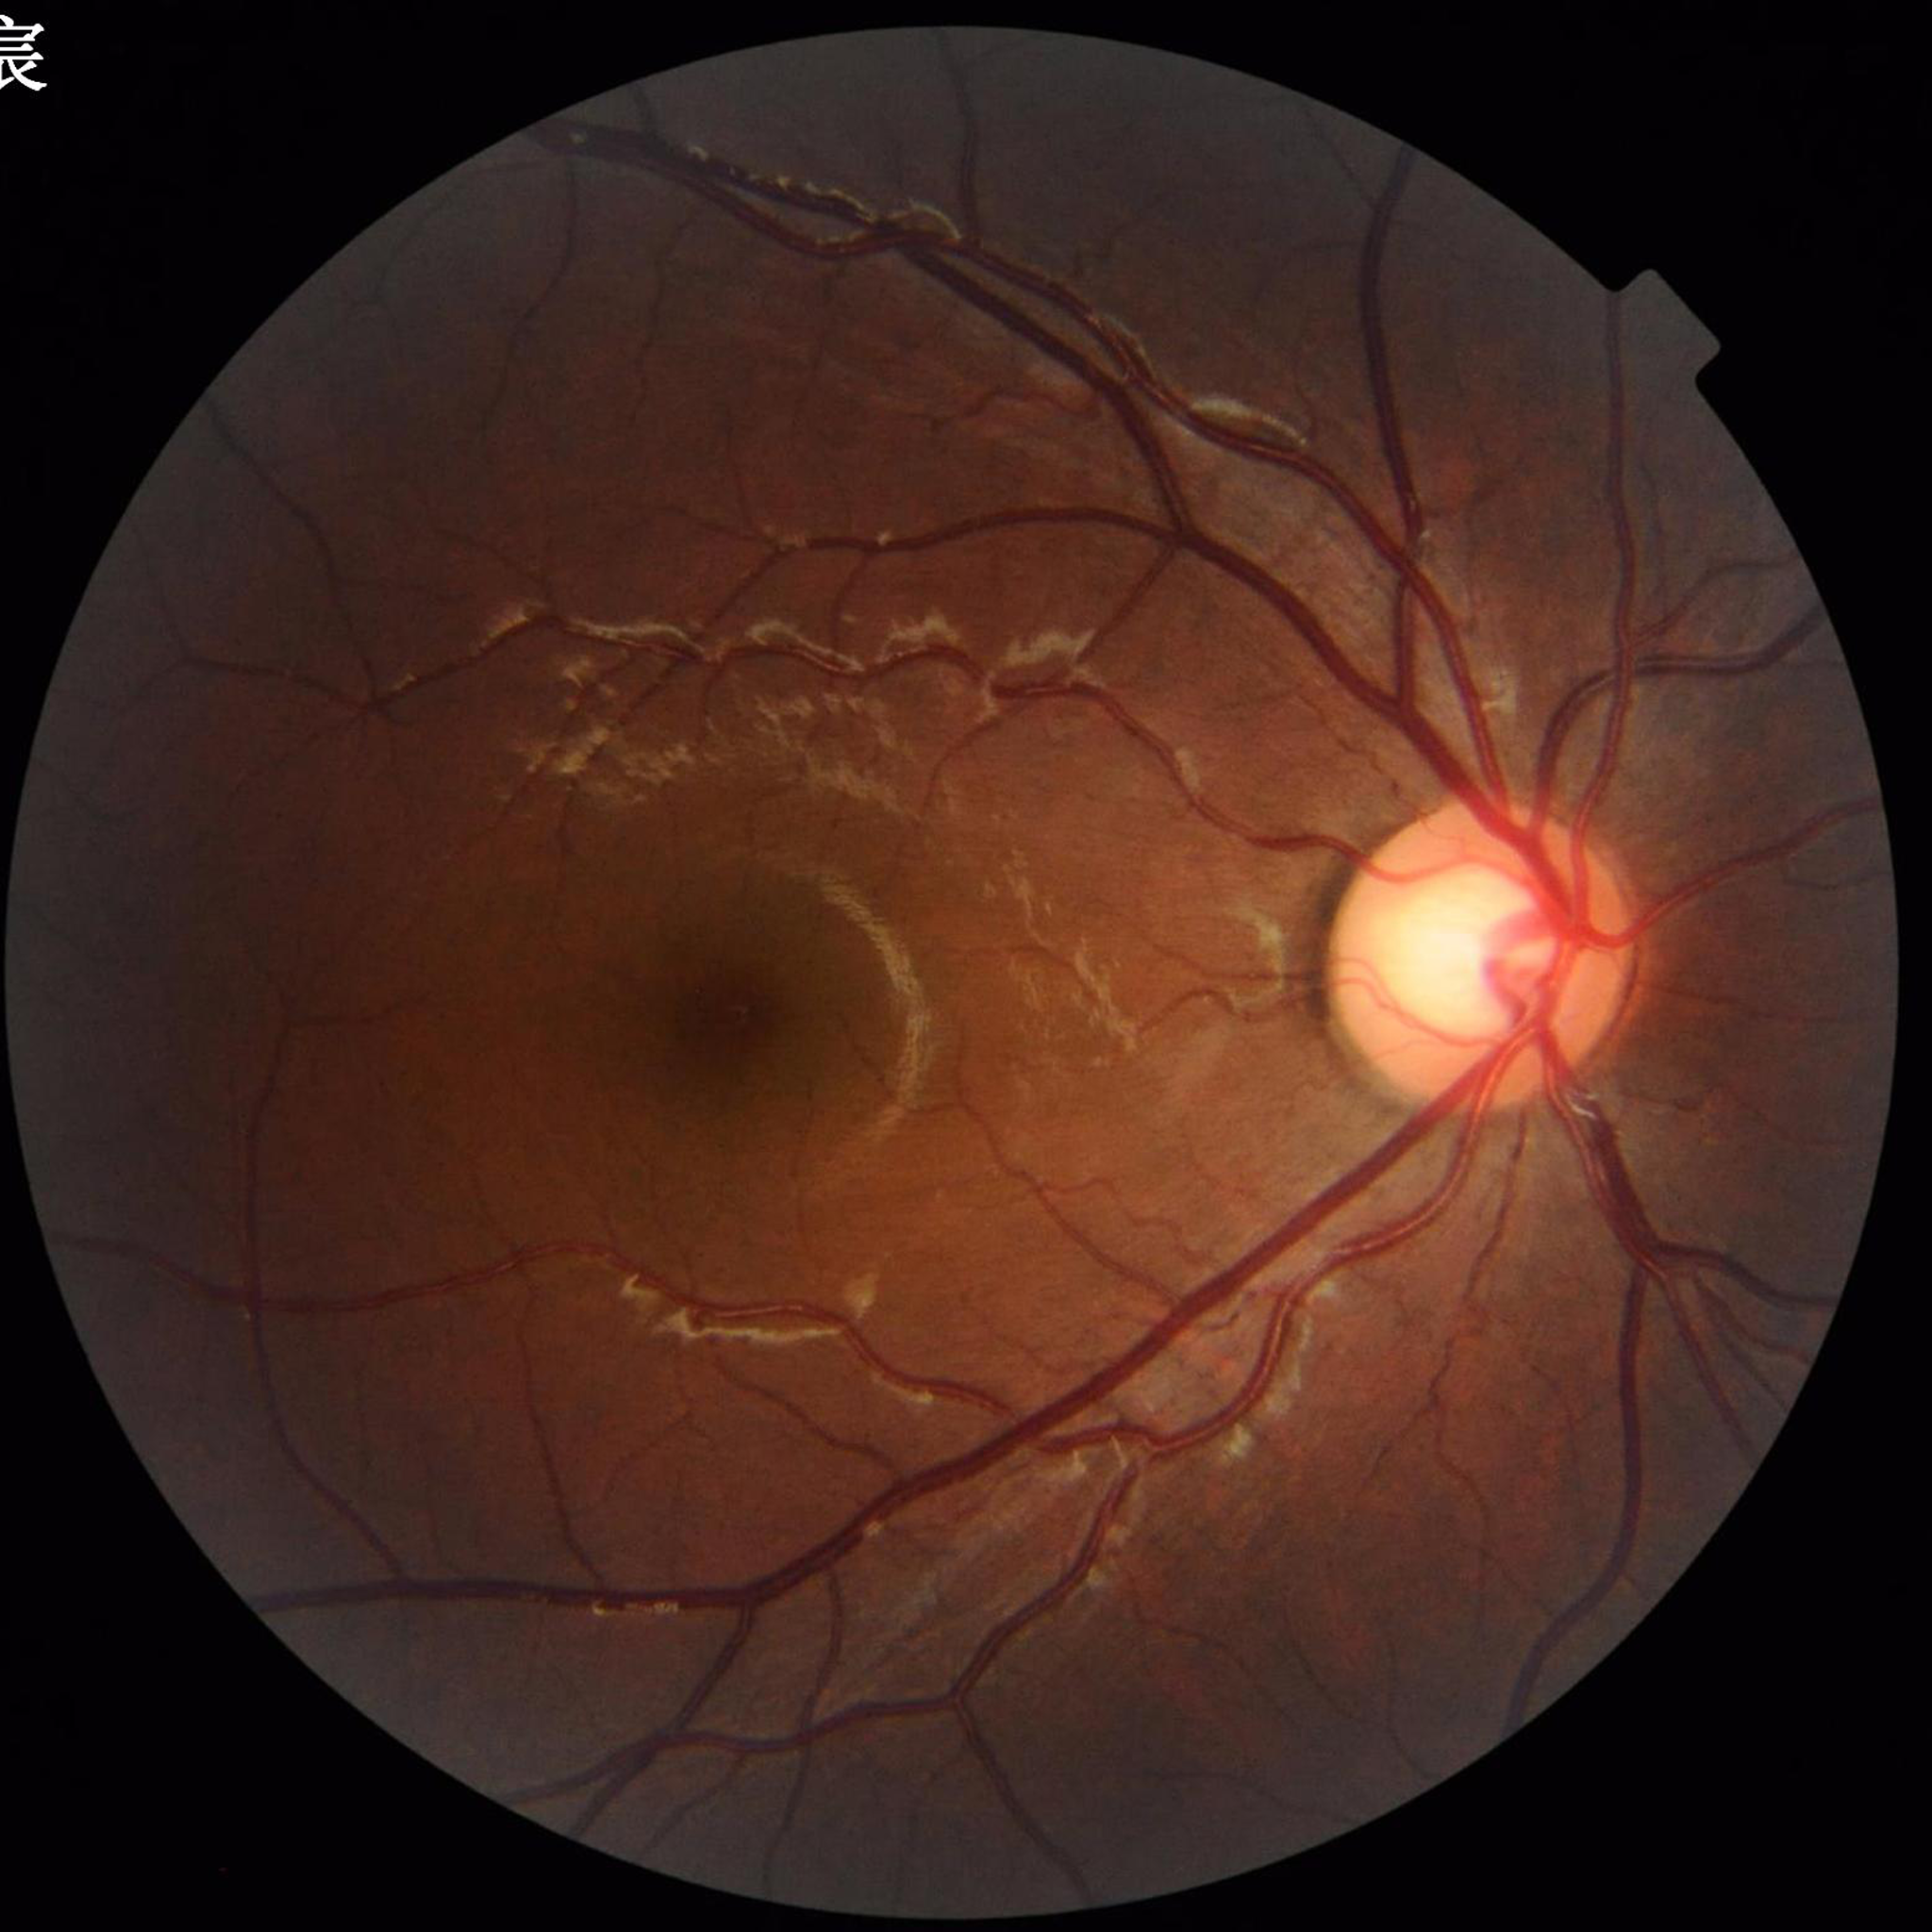
{"diagnosis": "no AMD, diabetic retinopathy, or glaucoma"}